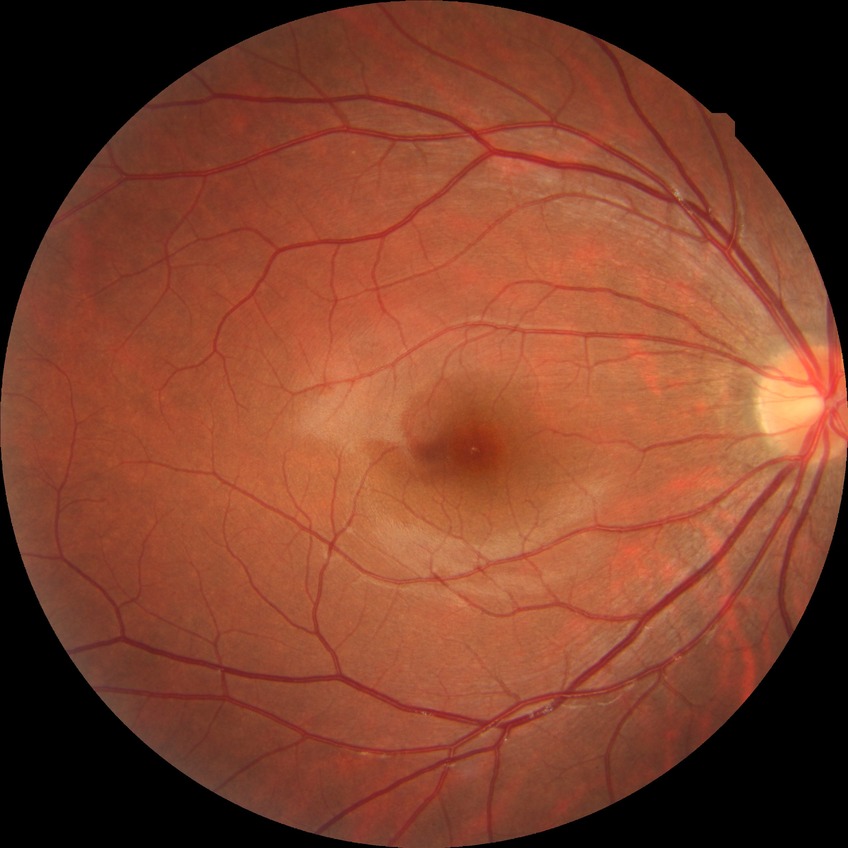
diabetic retinopathy (DR) = NDR (no diabetic retinopathy)